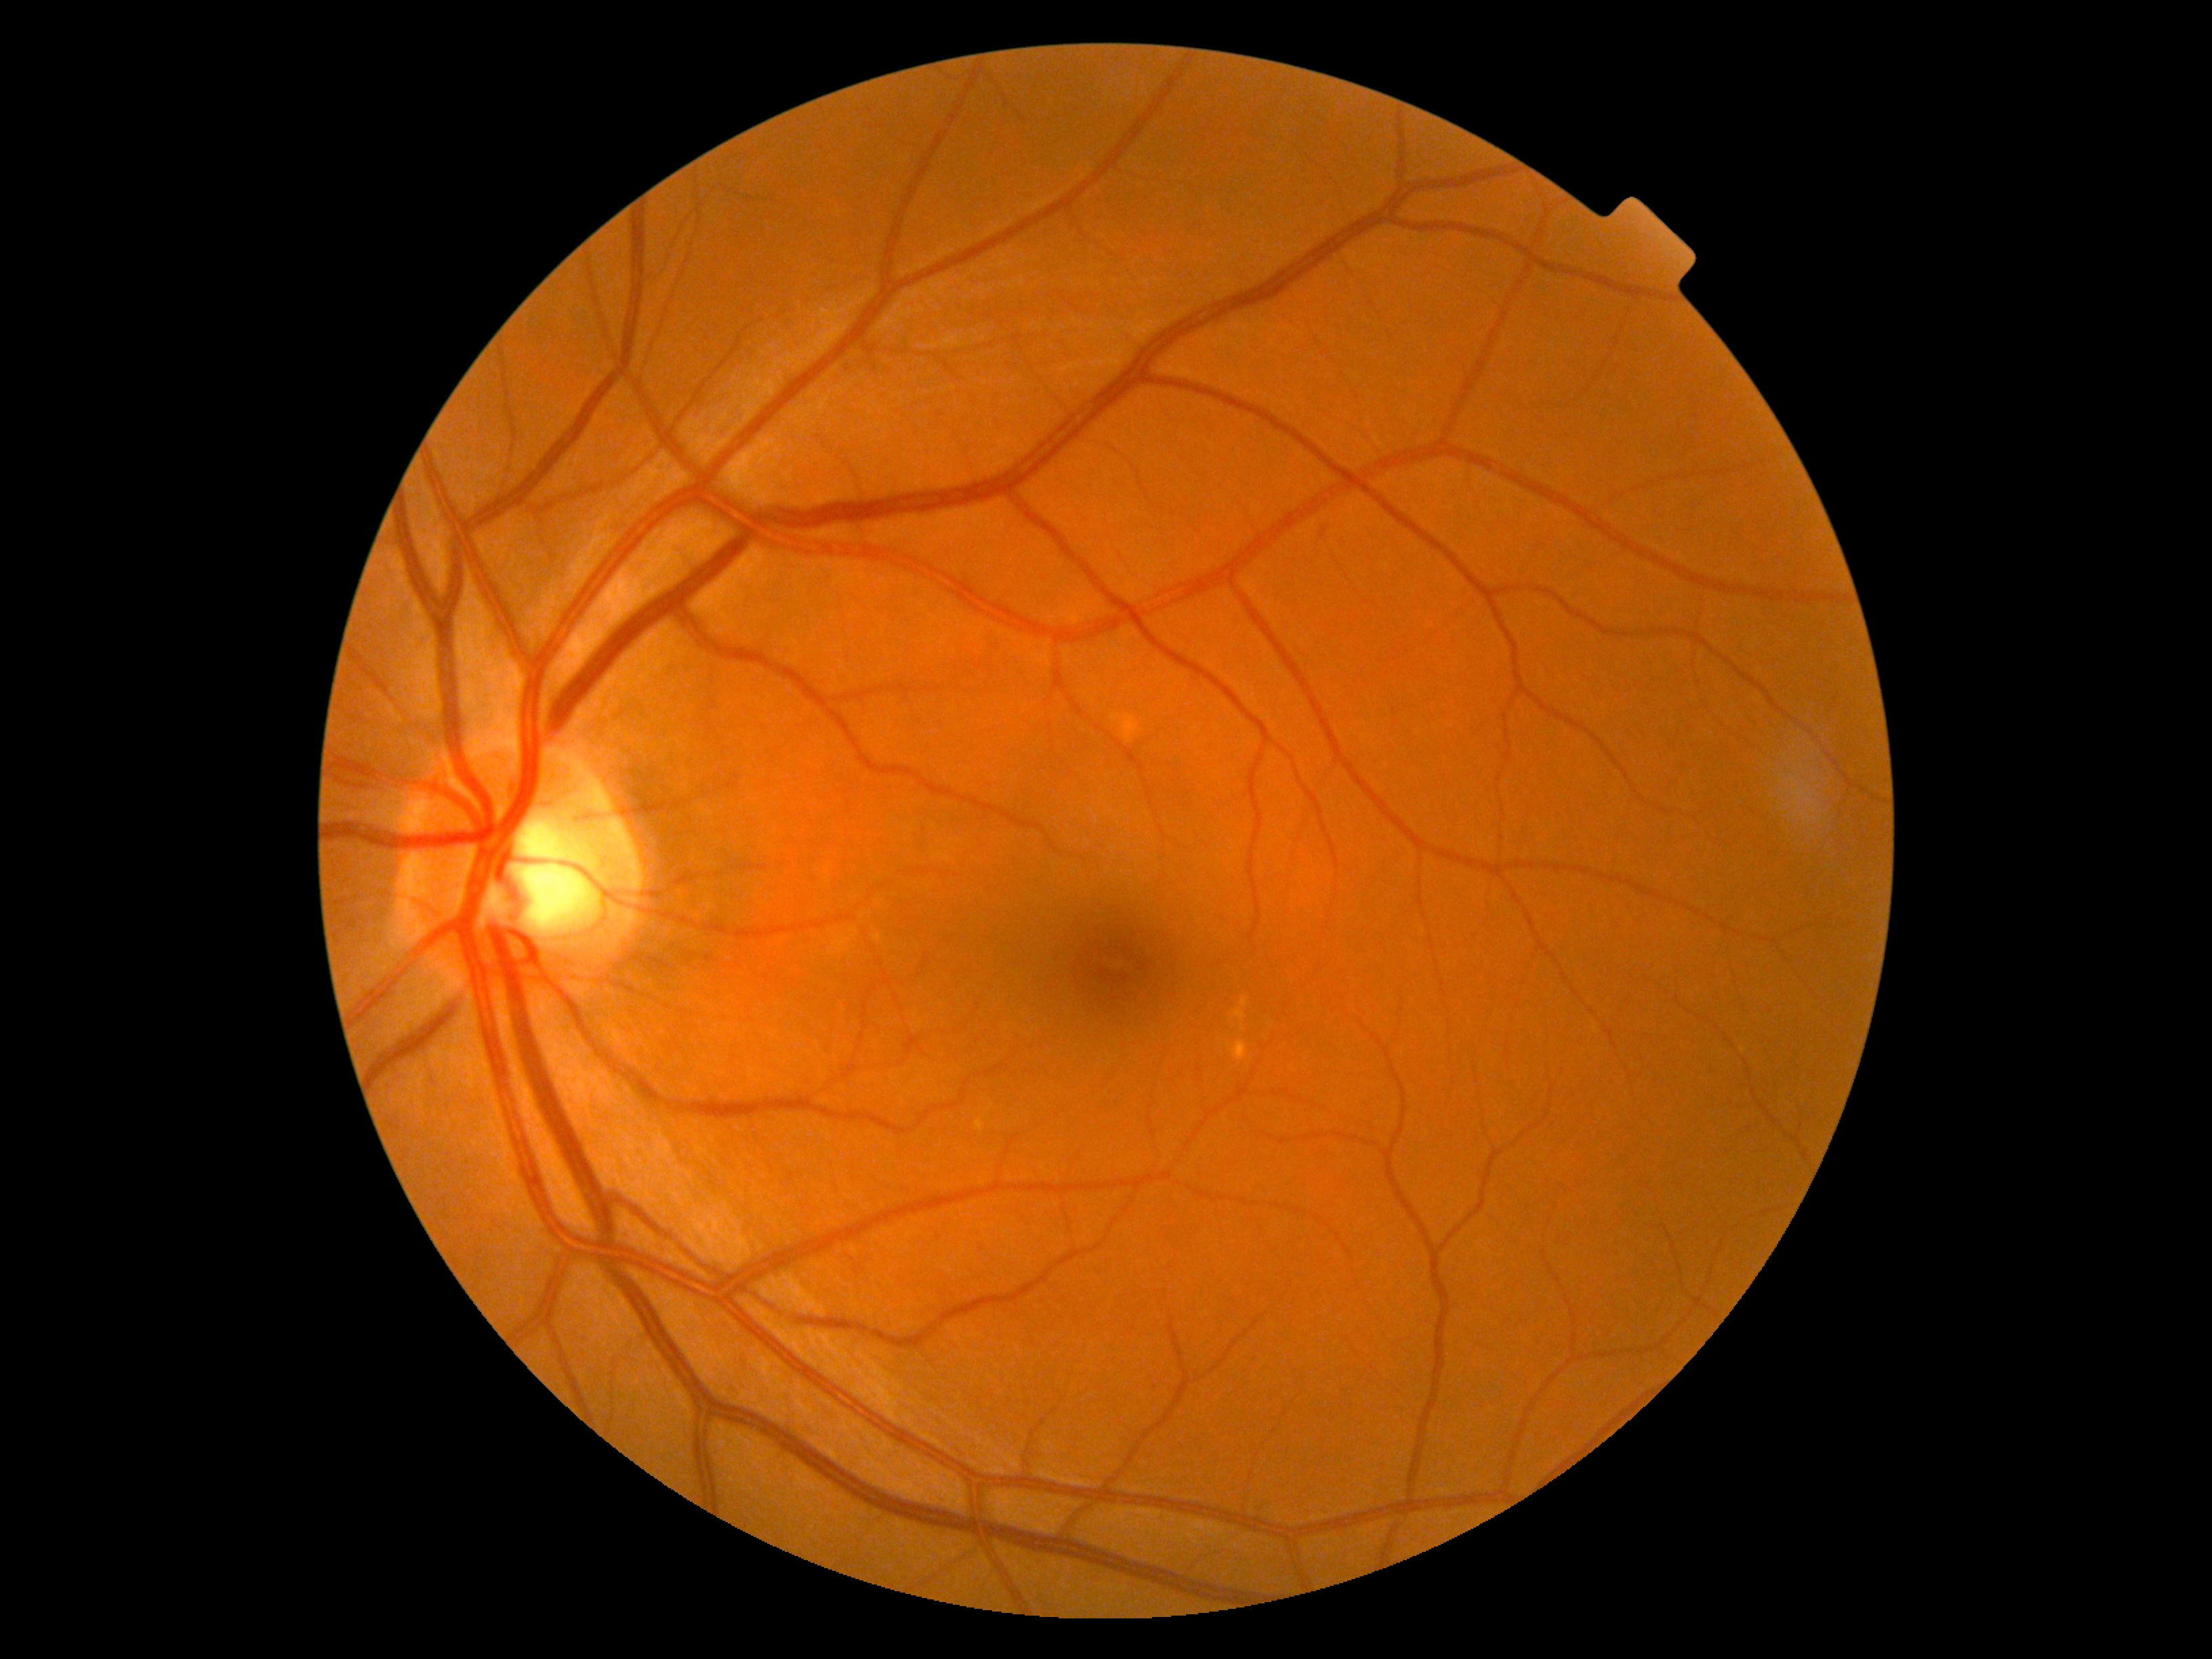

DR@grade 0 (no apparent retinopathy) — no visible signs of diabetic retinopathy.